Wide-field fundus photograph from neonatal ROP screening; 1440 by 1080 pixels — 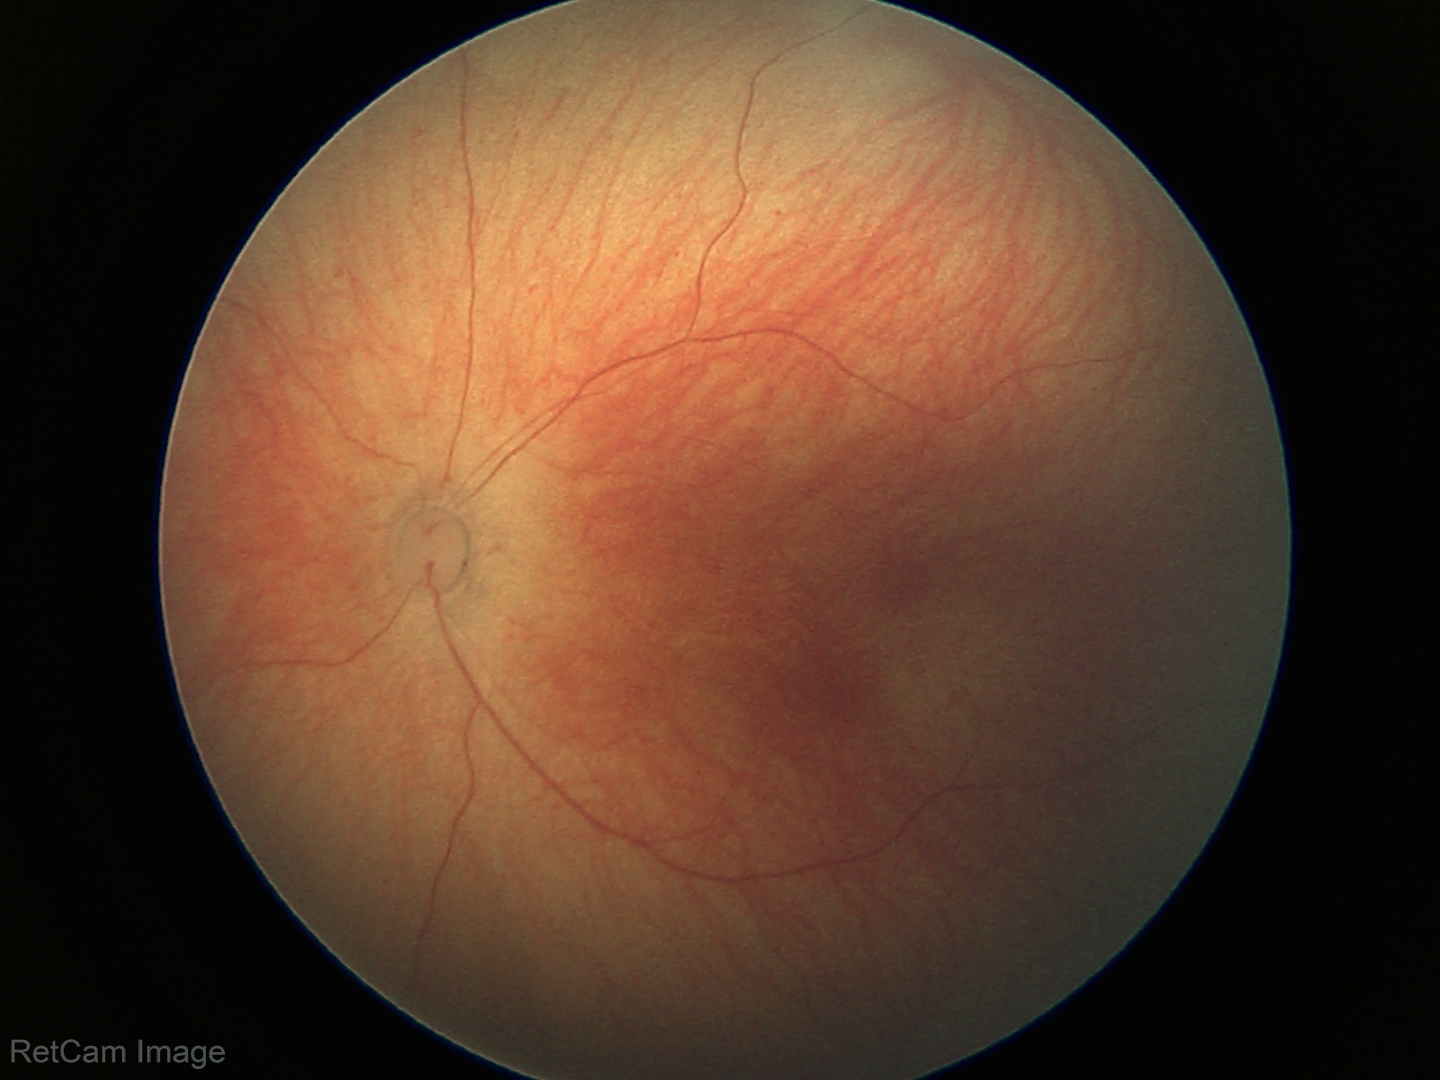

Physiological retinal appearance for postconceptual age.